Diabetic retinopathy graded by the modified Davis classification — 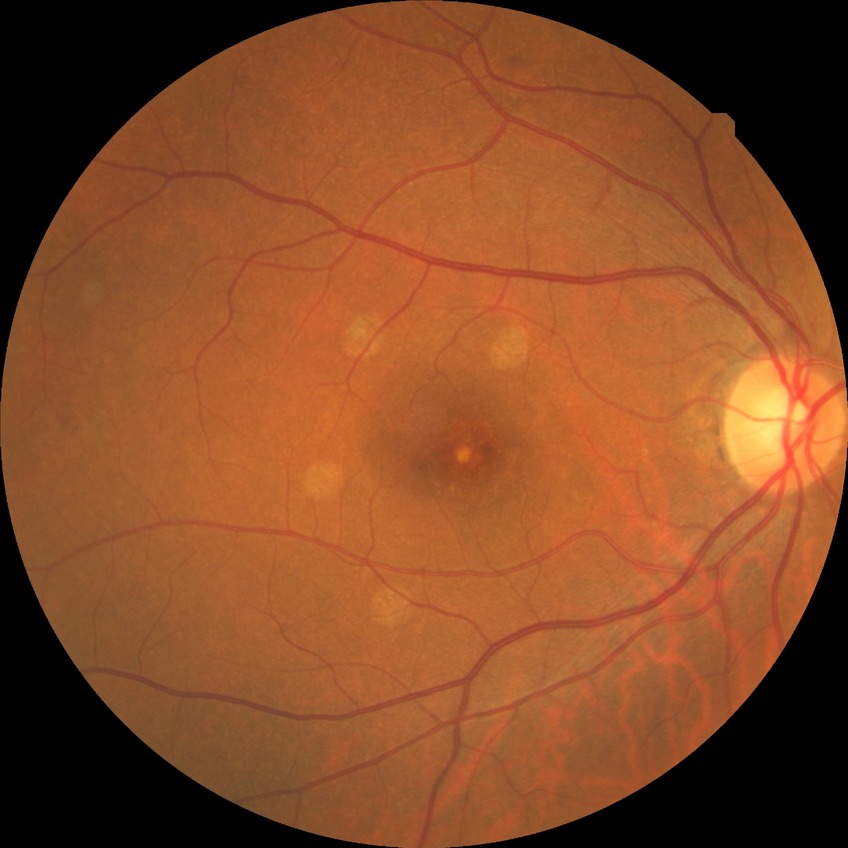 {"davis_grade": "no diabetic retinopathy"}